Natus RetCam Envision, 130° FOV; infant wide-field retinal image
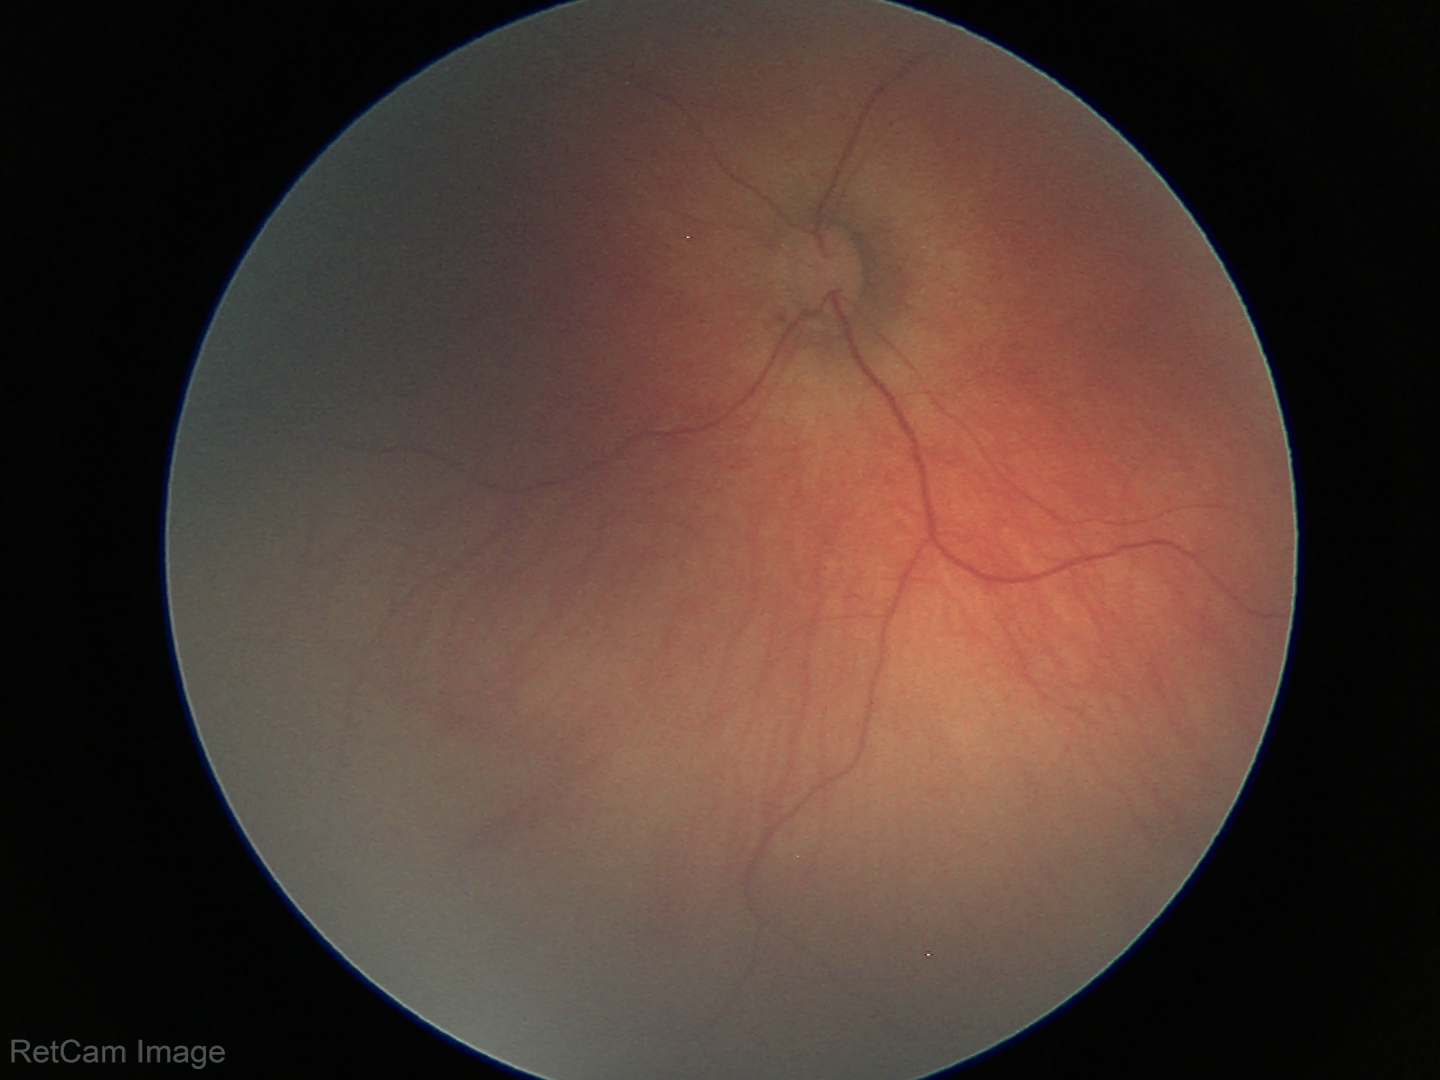 Screening examination with no abnormal retinal findings.